2352 by 1568 pixels — 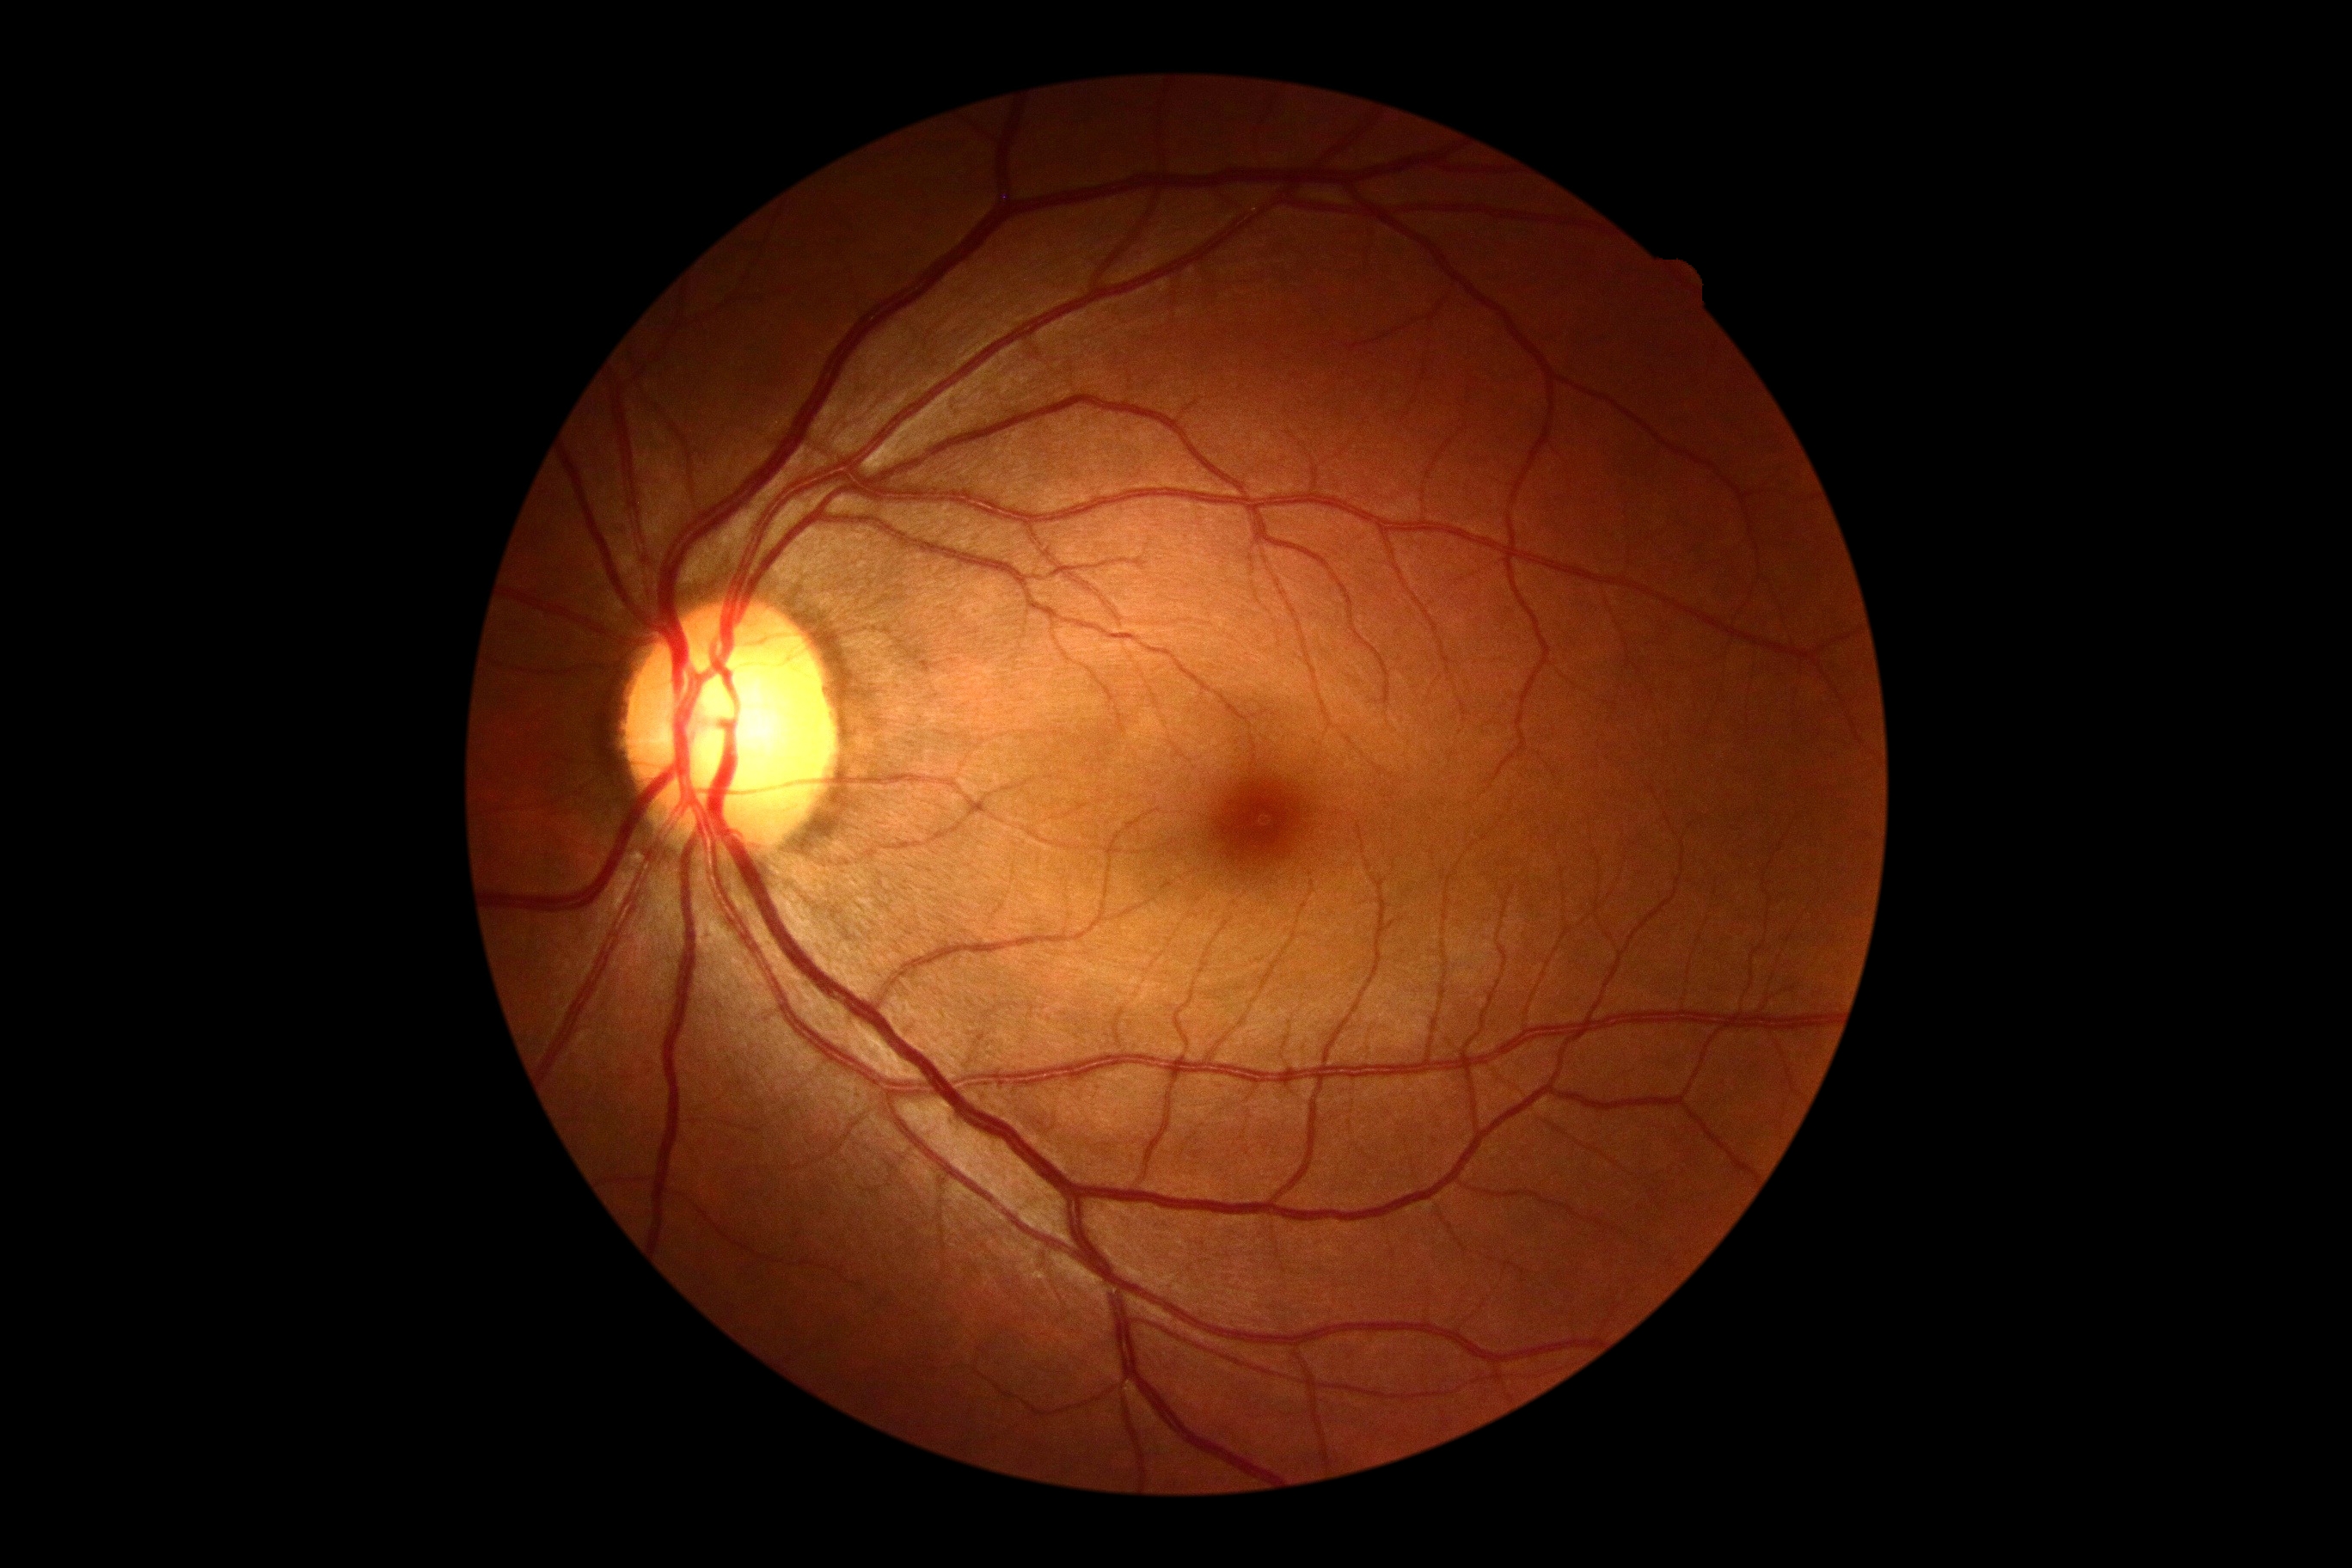

DR impression: negative for DR; retinopathy grade: 0 (no apparent retinopathy).